Image size 1971x1876:
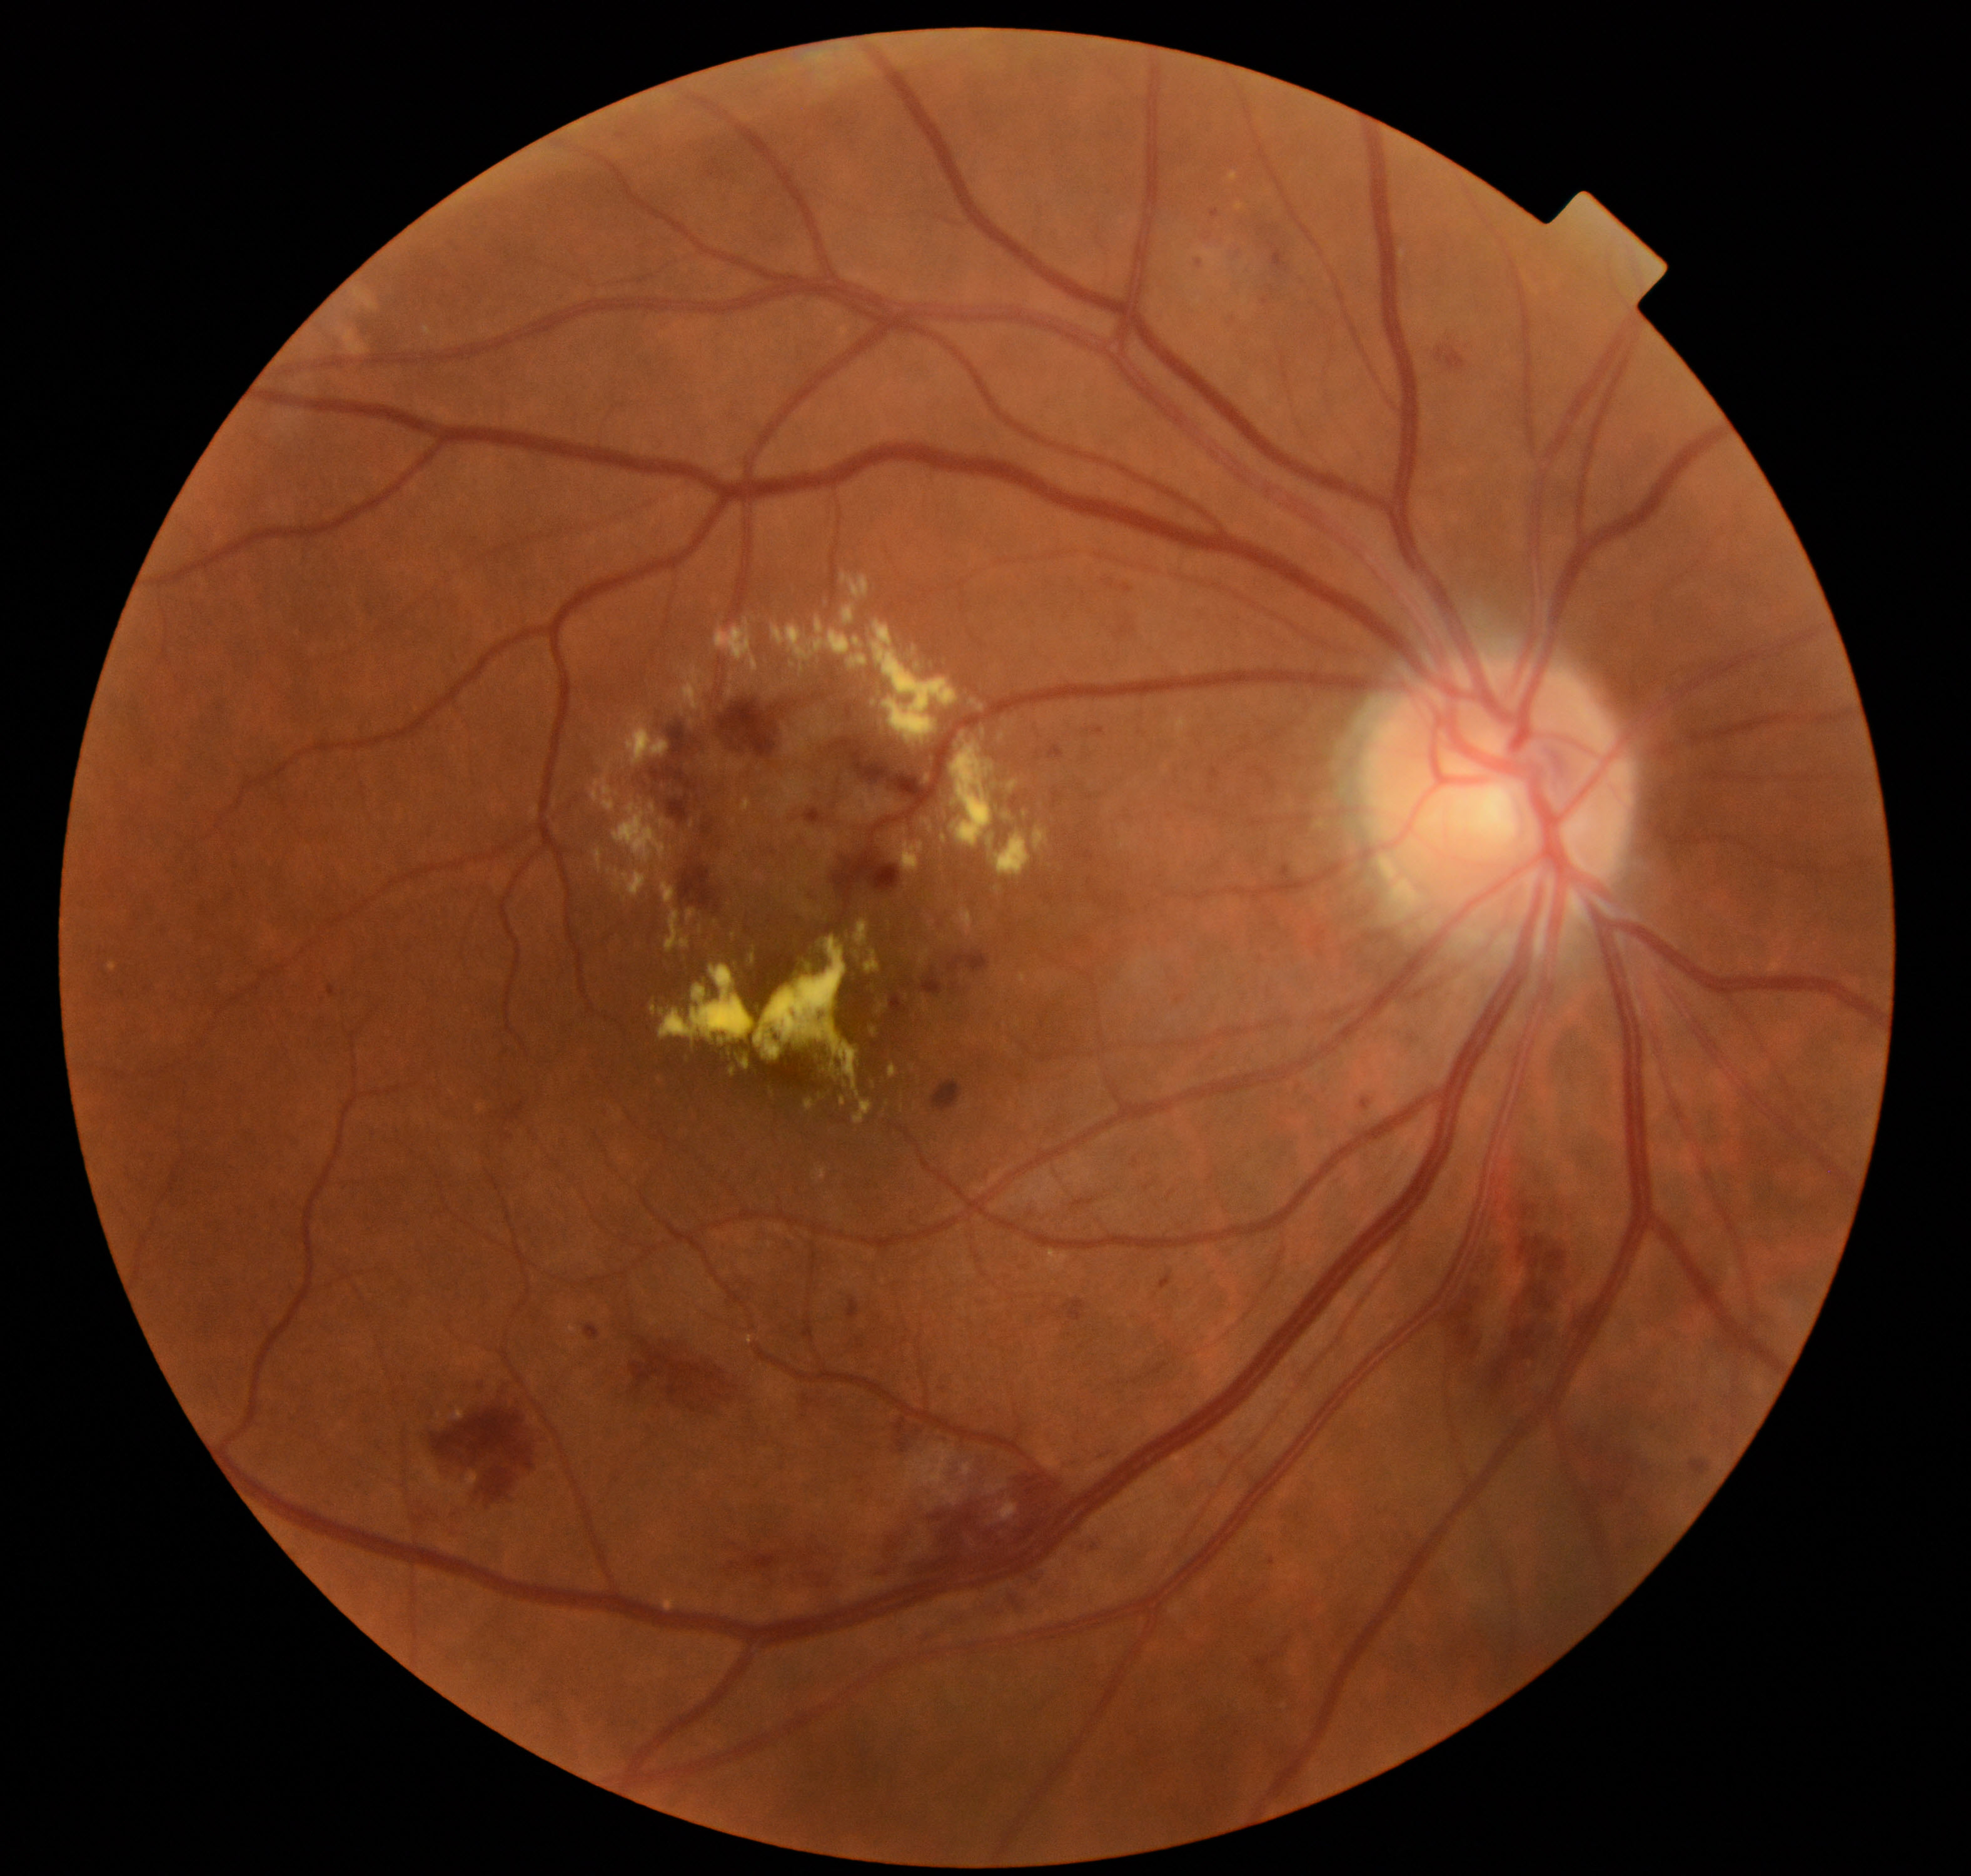

Diagnosis: moderate non-proliferative diabetic retinopathy. Features include microaneurysms with dot and blot hemorrhages or hard exudates, less than severe non-proliferative diabetic retinopathy, and/or with diabetic macular edema.